Image size 848x848. Davis DR grading:
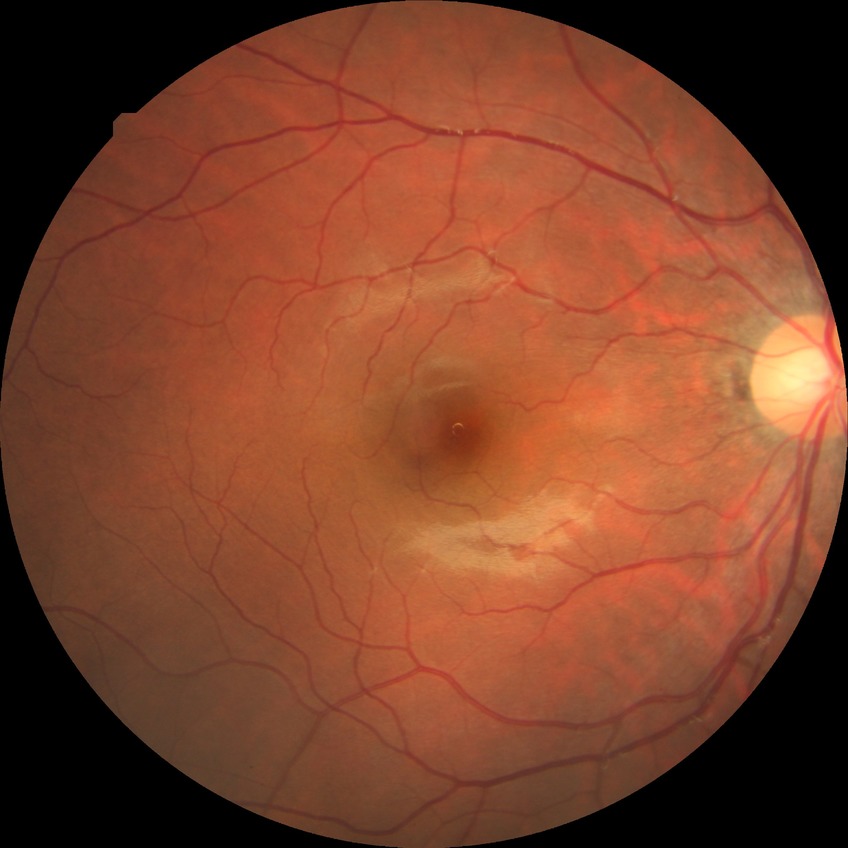 DR impression: no signs of DR | DR grade: NDR.